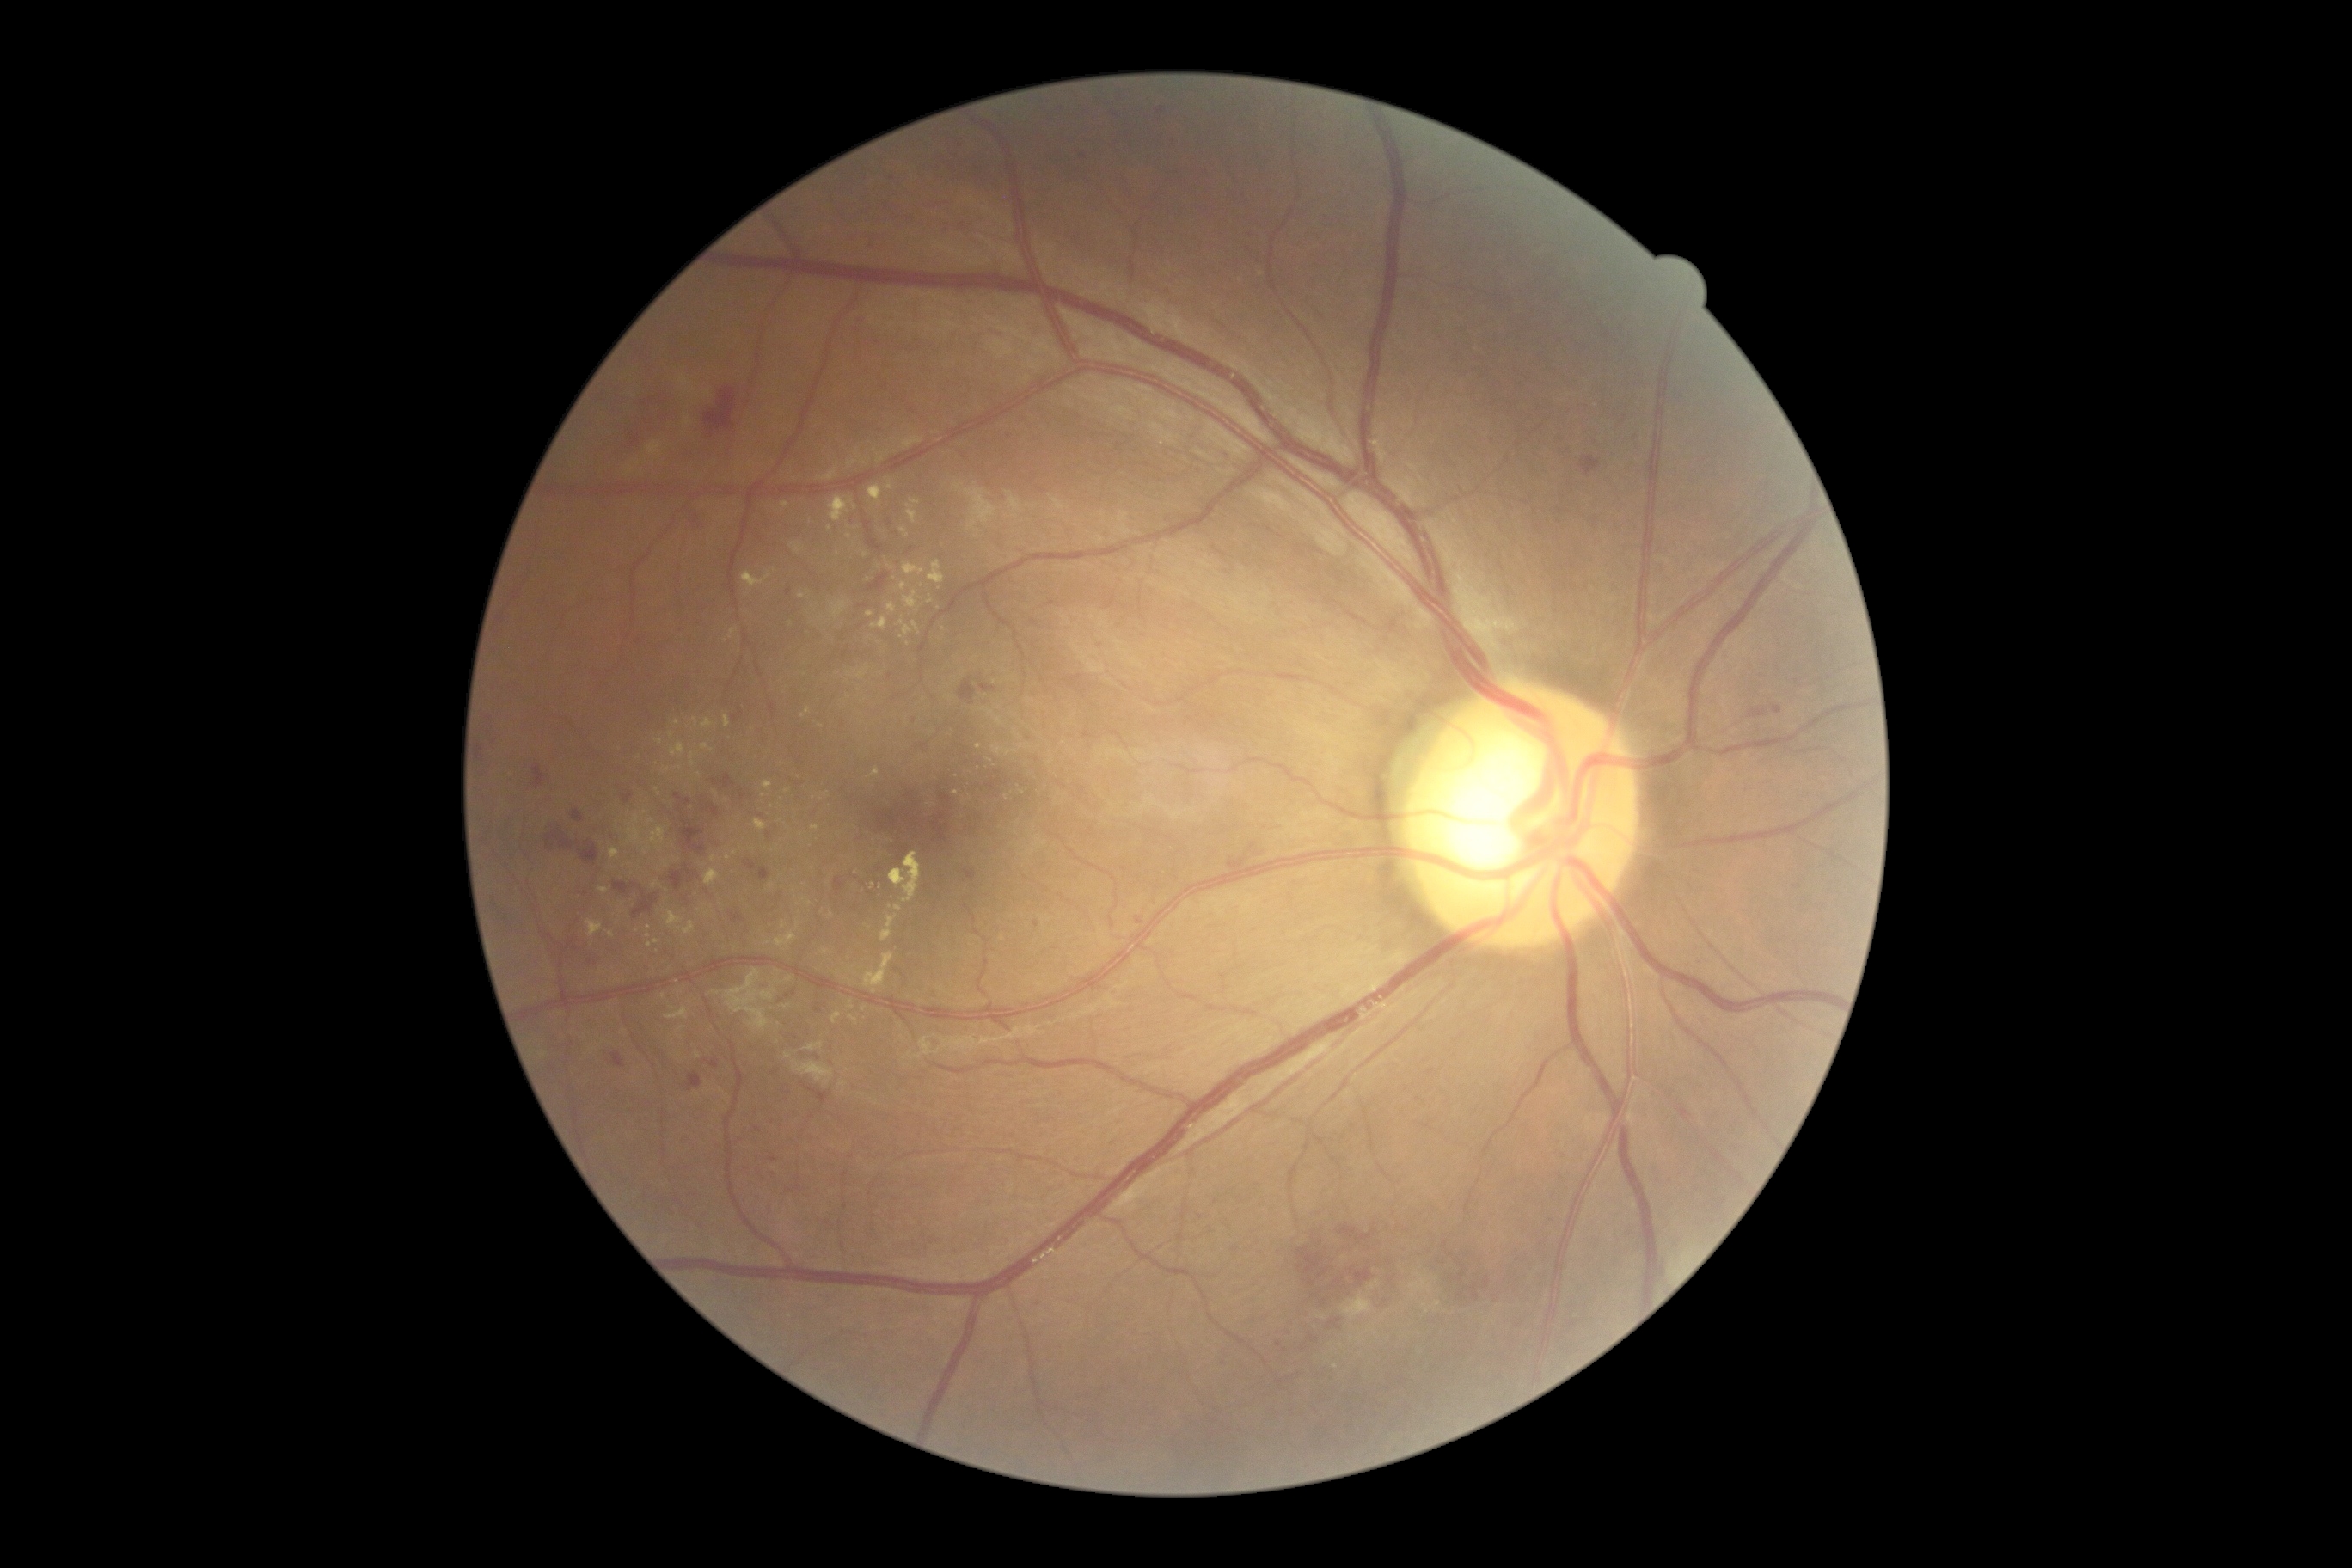 {"partial":true,"dr_grade":2,"lesions":{"ex":[[866,613,874,618],[912,622,921,634],[742,572,771,591],[850,1001,854,1010],[781,503,792,510],[665,912,682,929],[790,542,805,554],[898,620,914,635],[831,1012,842,1024]],"ex_small_approx":[[831,916],[826,952],[649,936],[644,814],[650,822],[722,1091],[716,993],[855,508]]}}